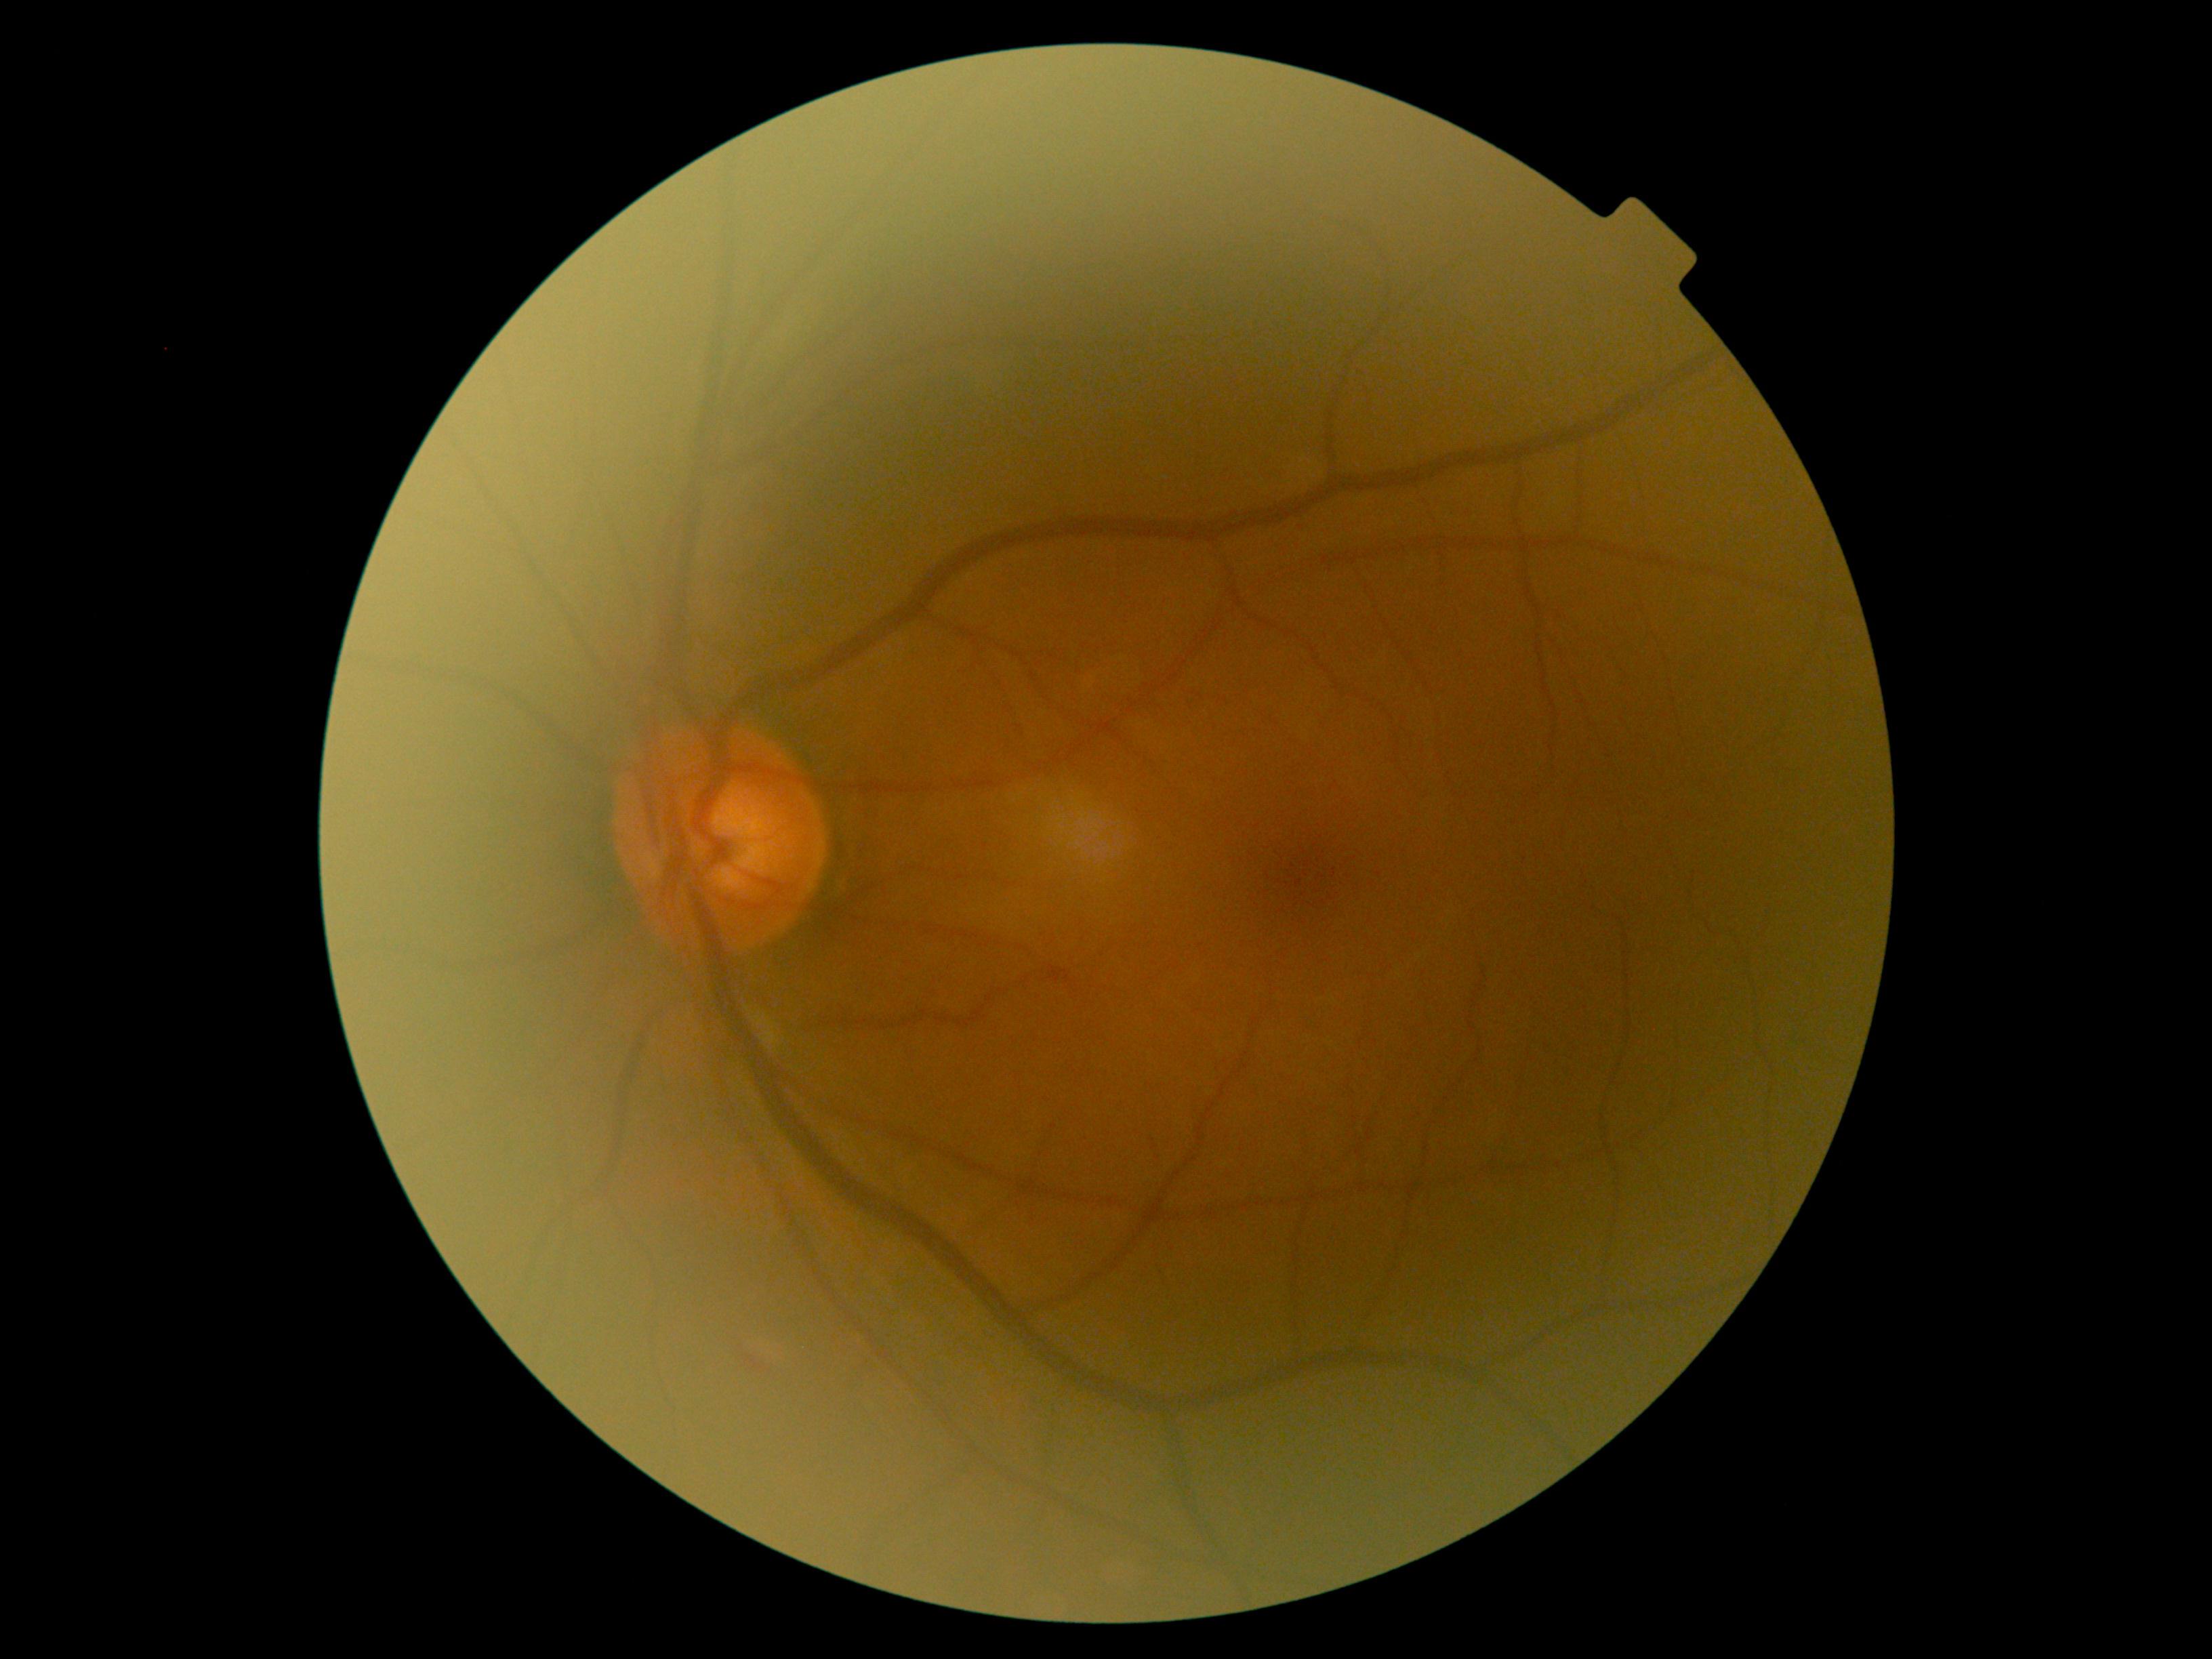
Diabetic retinopathy grade: moderate non-proliferative diabetic retinopathy (2).